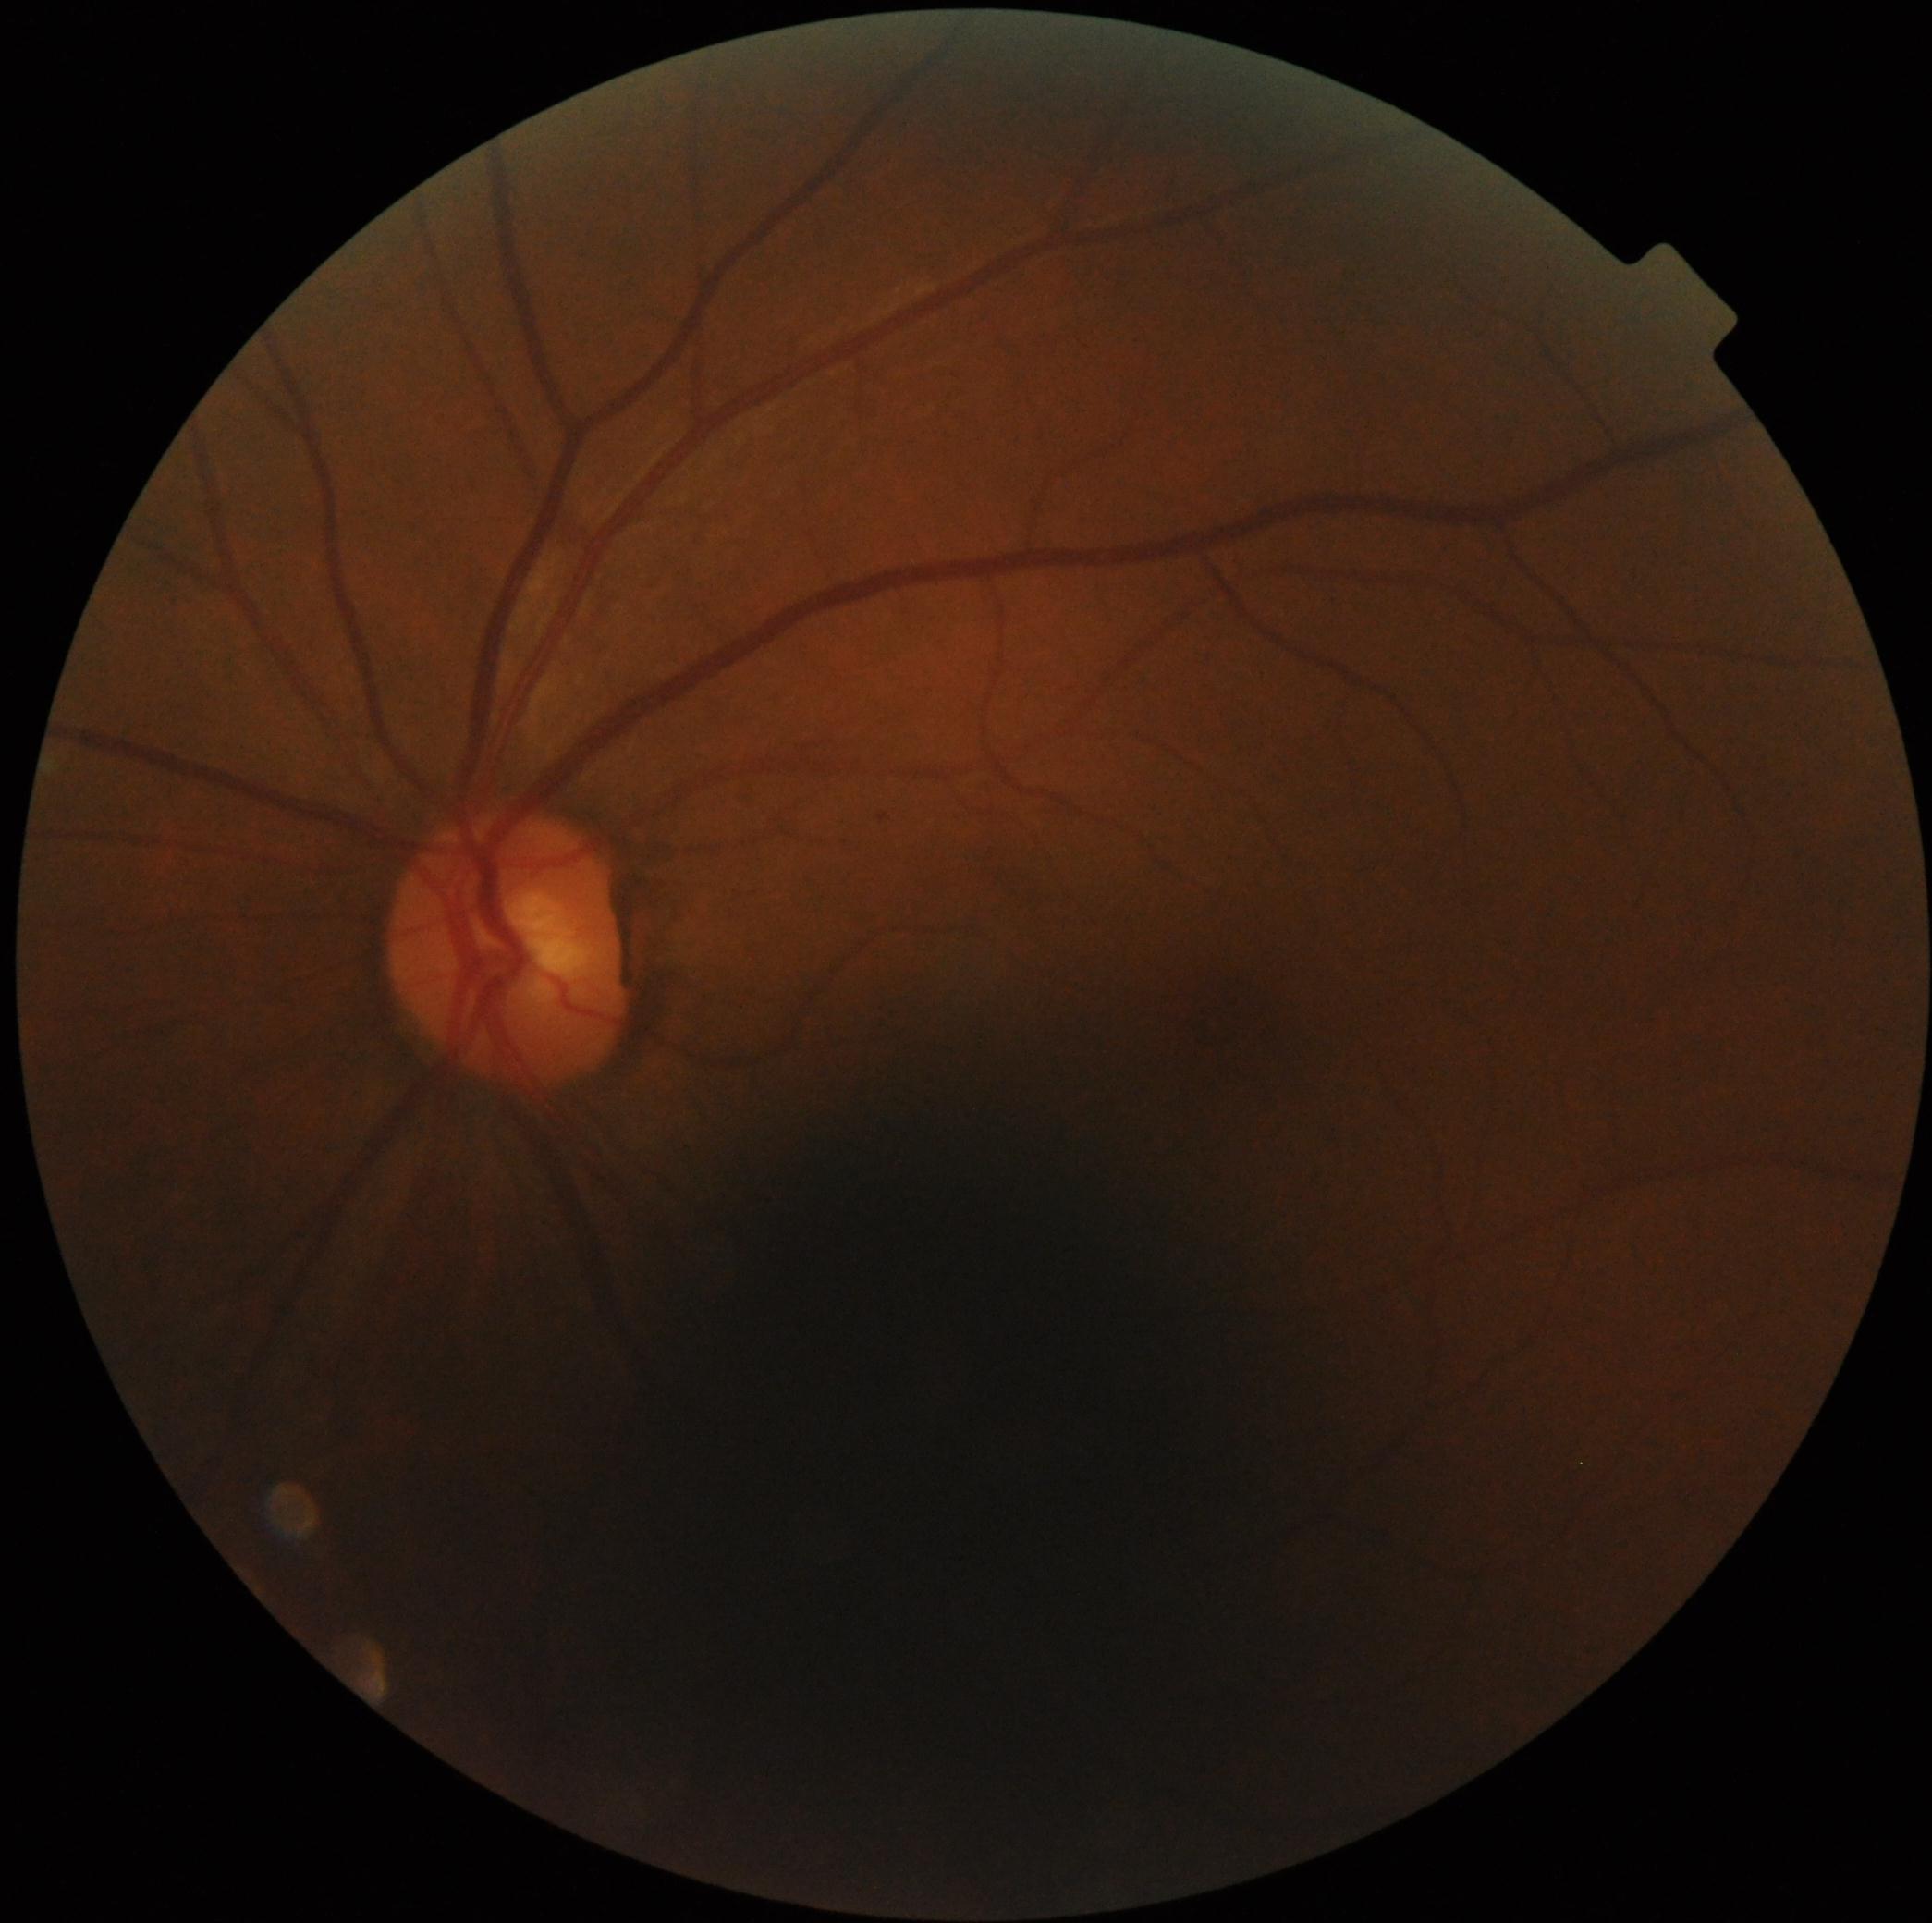 DR grade = mild non-proliferative diabetic retinopathy (1) — presence of microaneurysms only